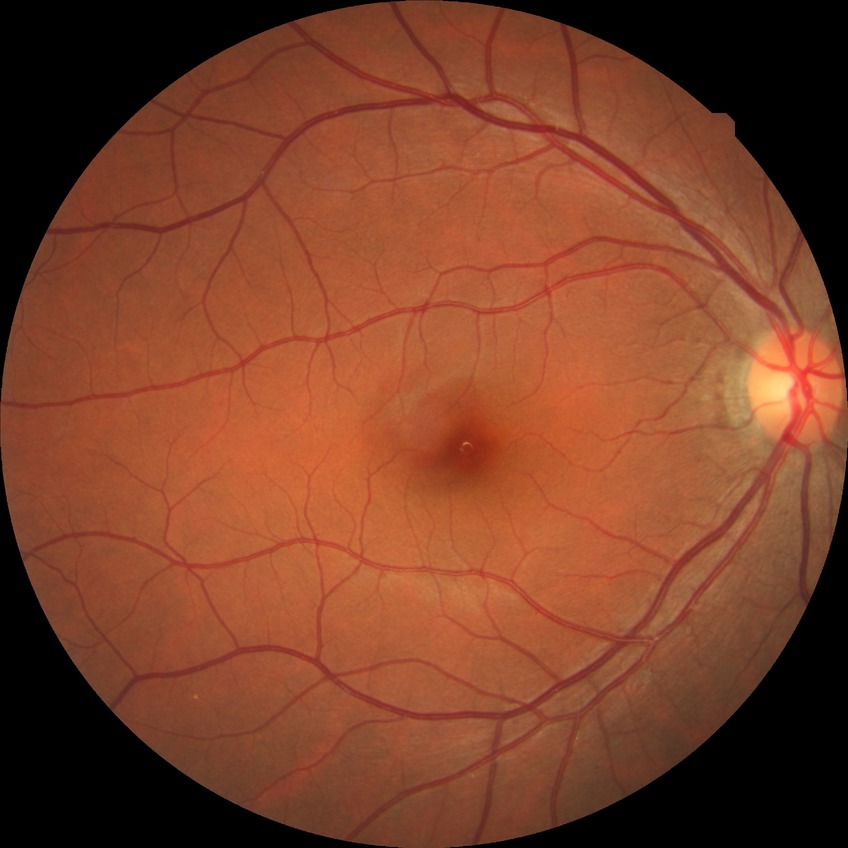 {
  "davis_grade": "no diabetic retinopathy"
}